ONH-centered crop from a color fundus image: 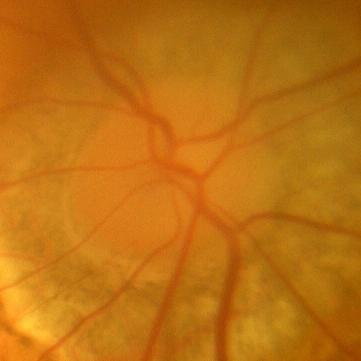 Demonstrates no glaucomatous findings.